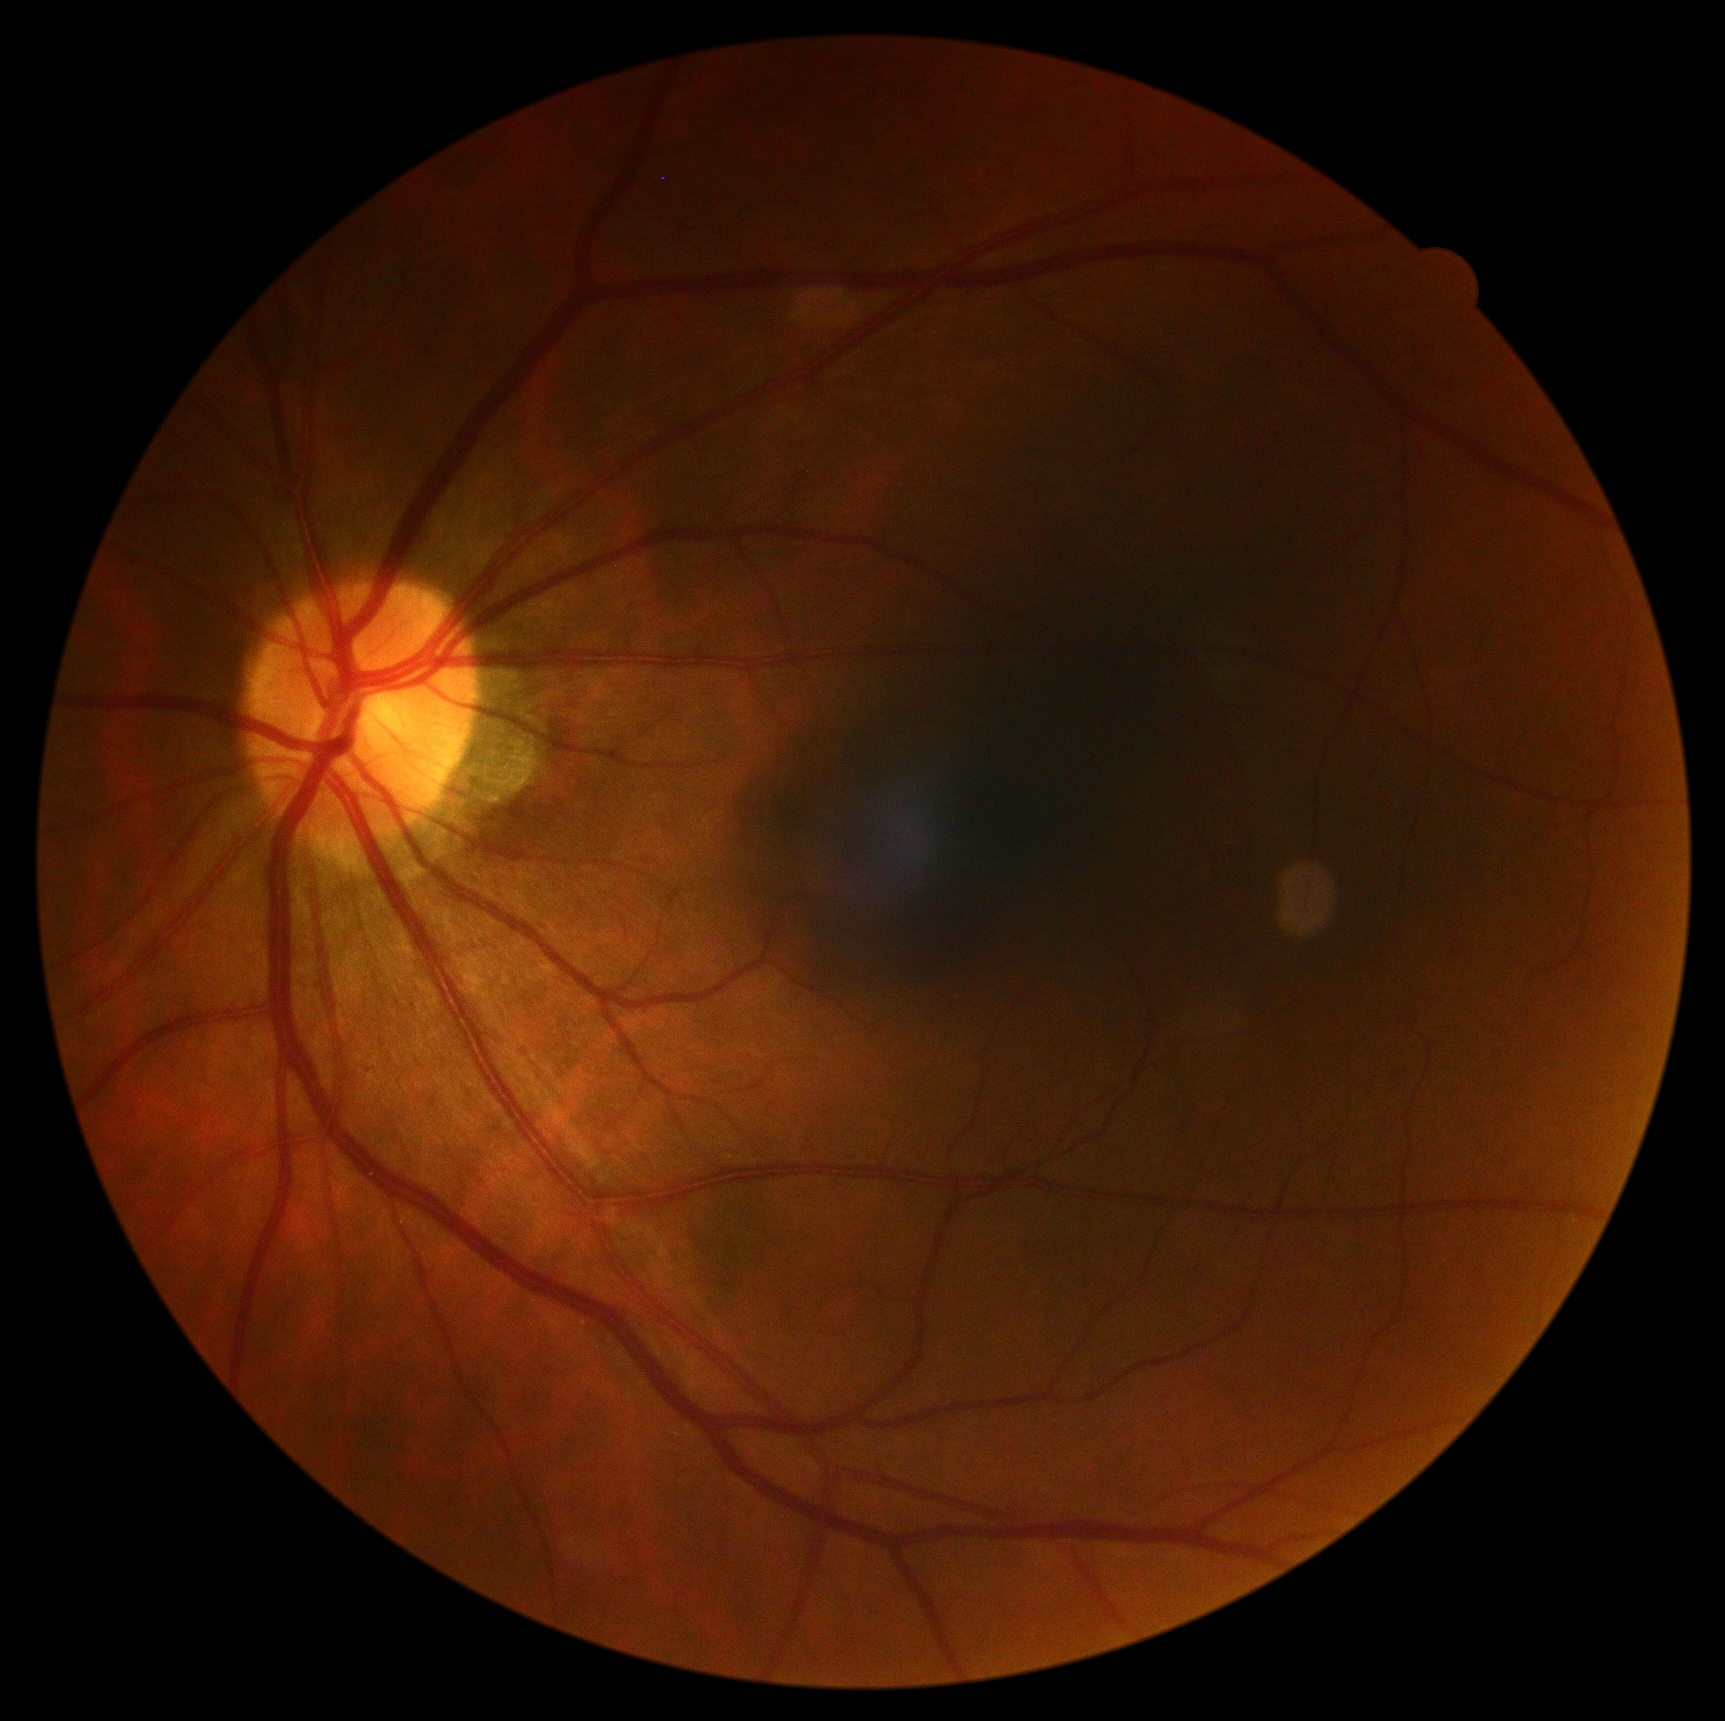
diabetic retinopathy (DR): 0.